1440 by 1080 pixels · pediatric retinal photograph (wide-field): 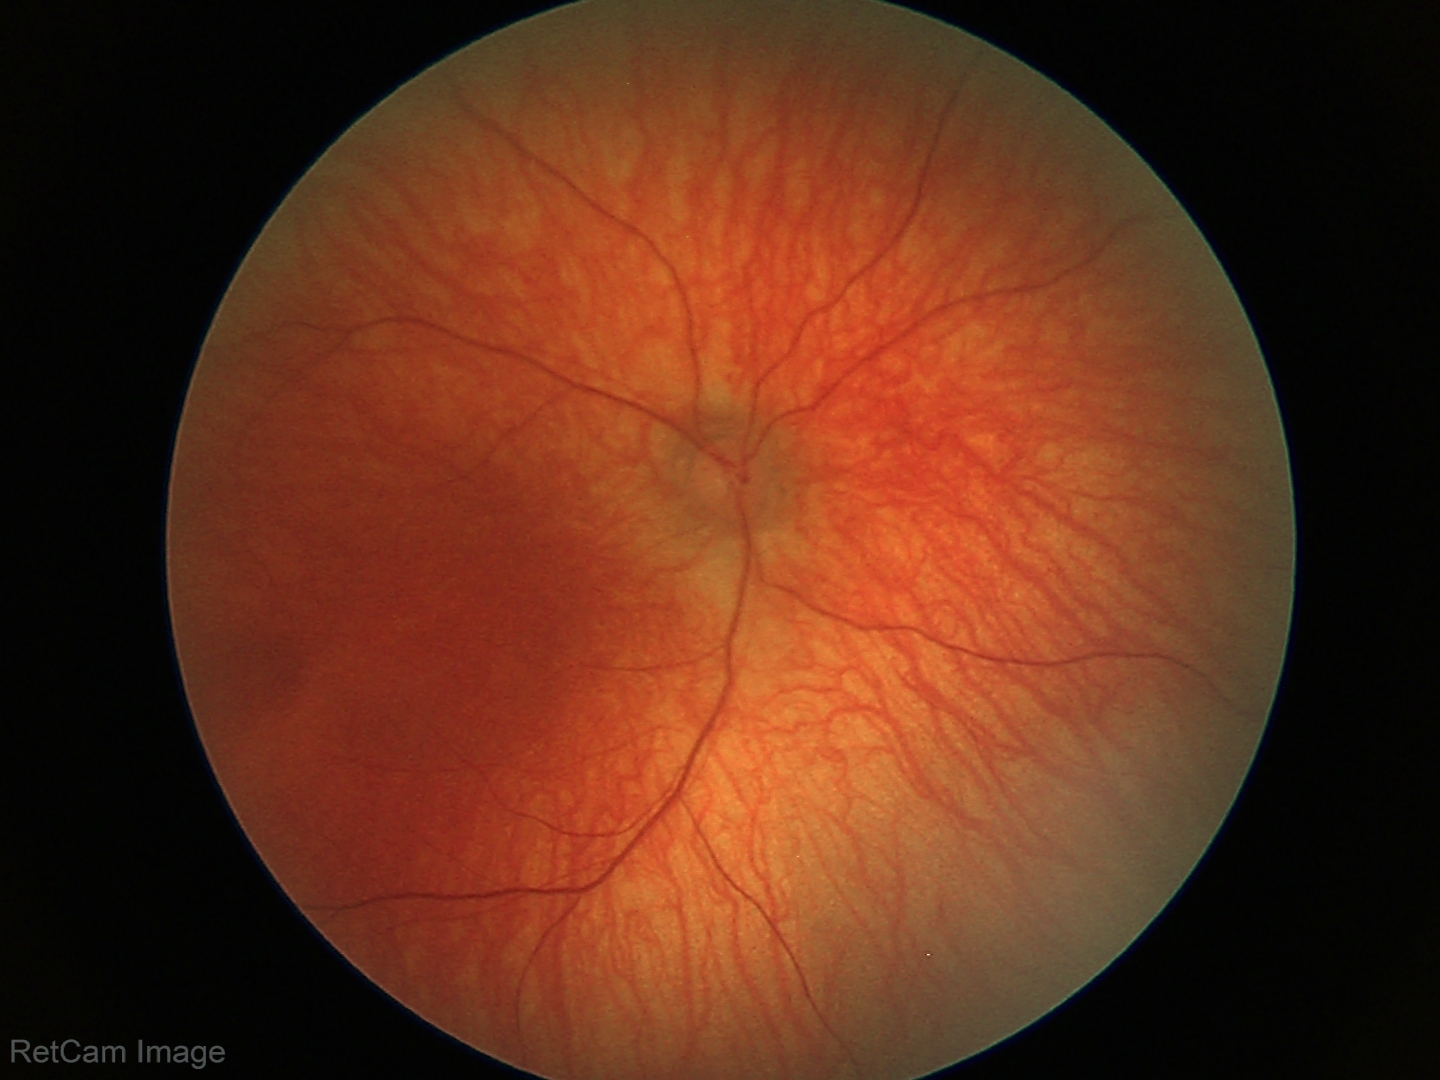

Normal screening examination.